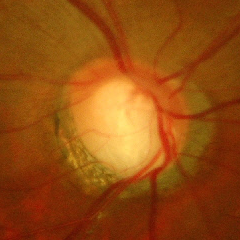
Glaucoma assessment = advanced glaucomatous optic neuropathy.